Graded on the modified Davis scale
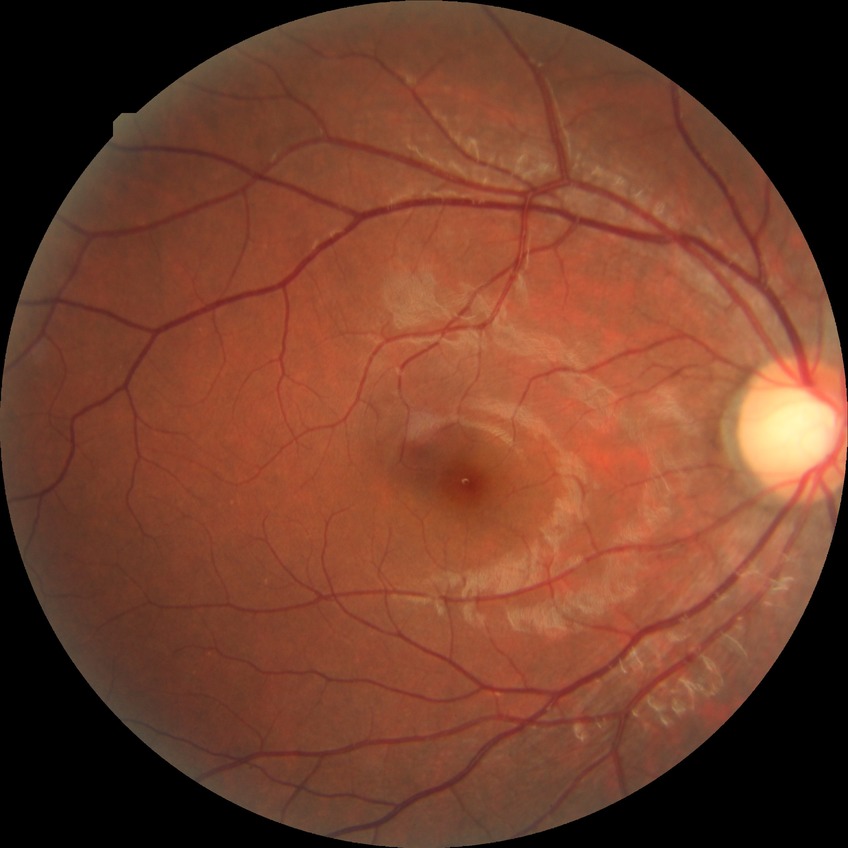

DR stage is NDR.